Graded on the modified Davis scale:
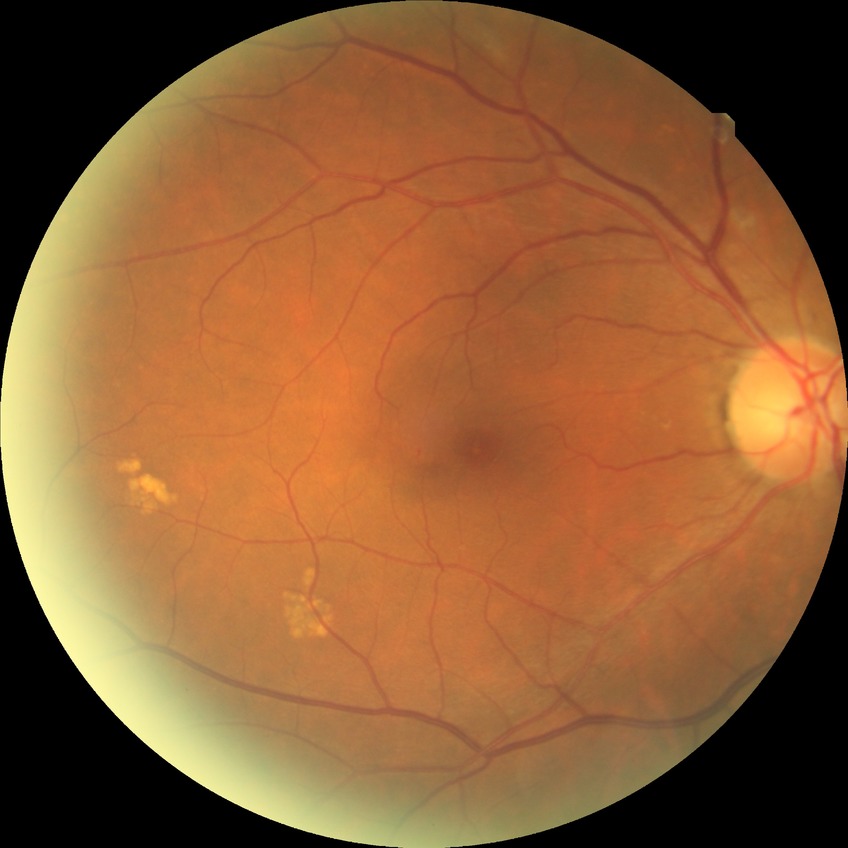 Diabetic retinopathy (DR): no diabetic retinopathy (NDR).